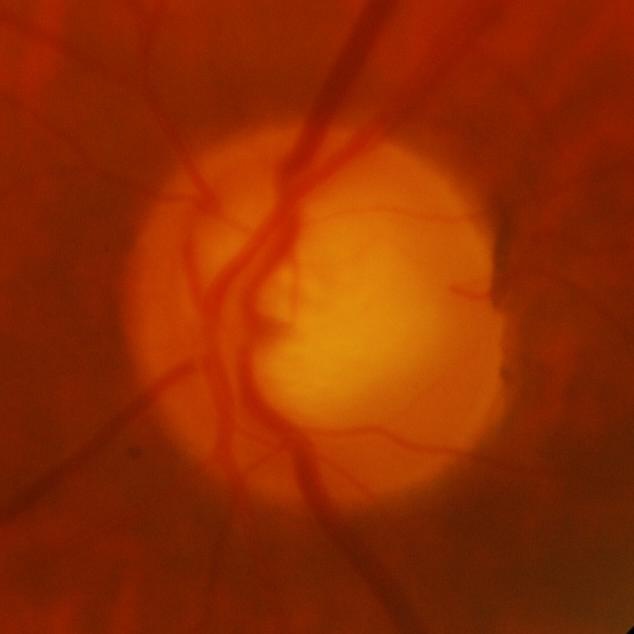 Glaucomatous changes are present. This optic disc photograph shows glaucomatous findings.